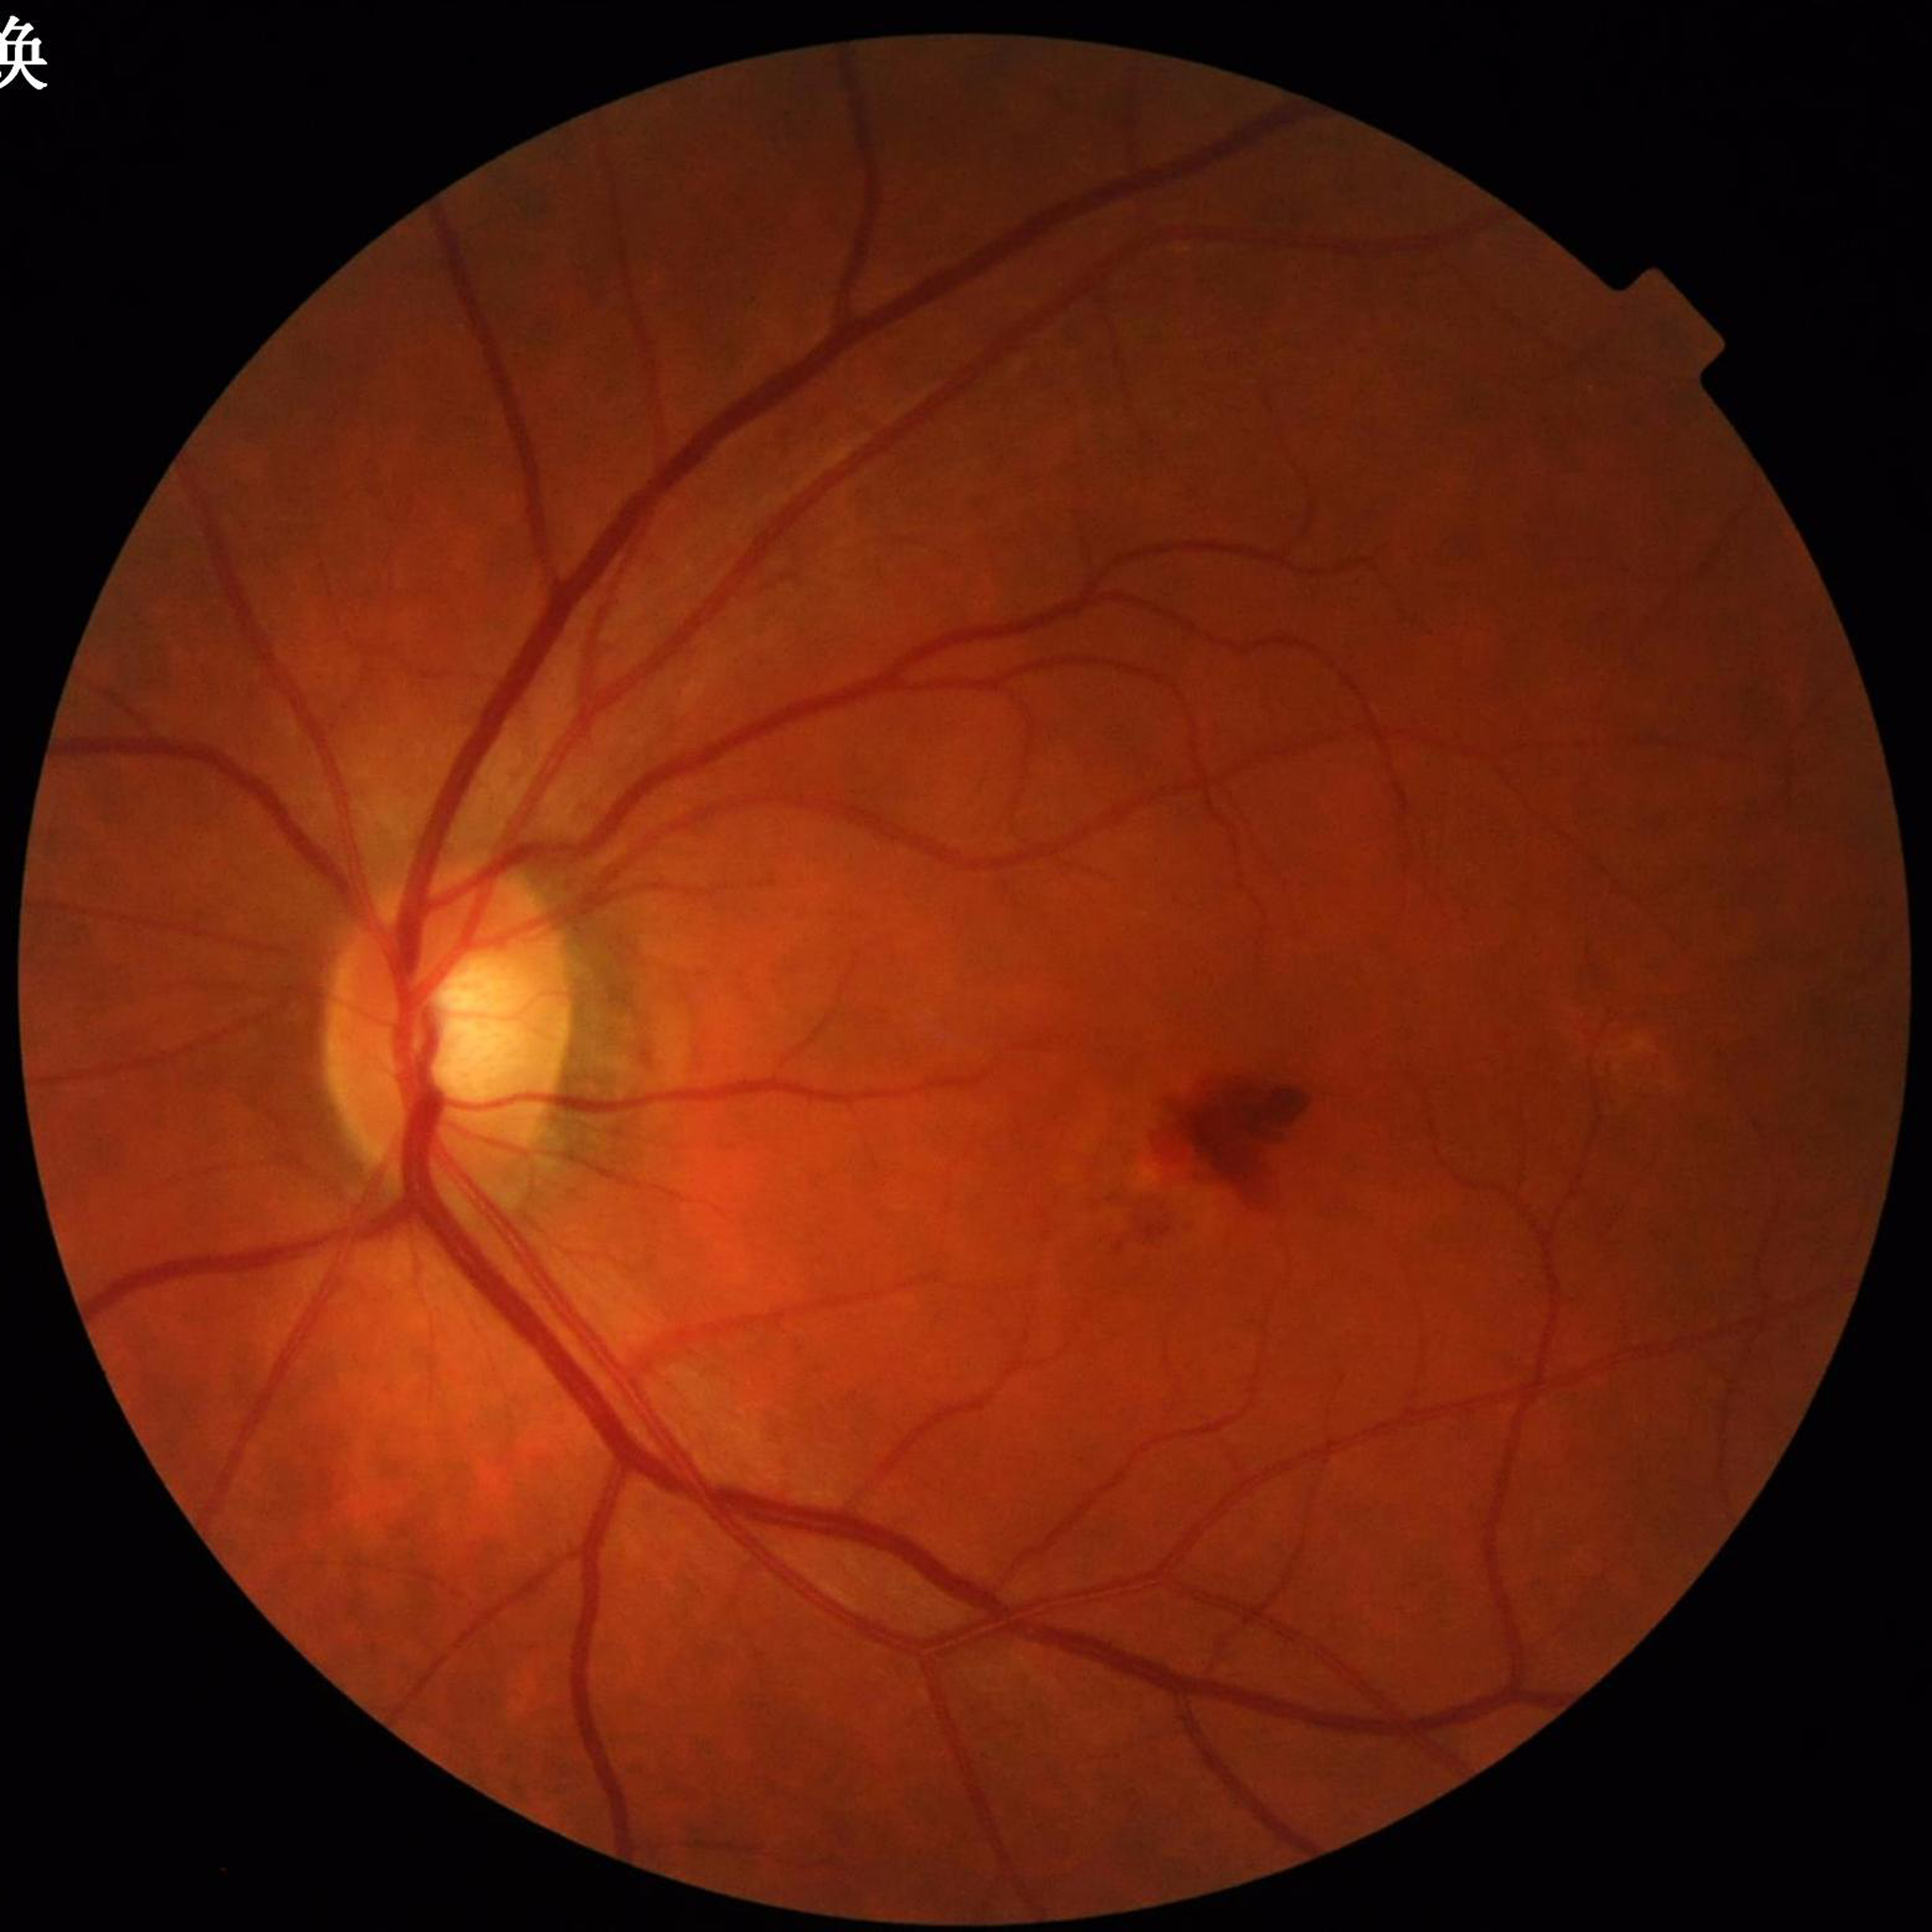

Automated quality assessment: no quality issues identified. Color fundus photograph from a patient diagnosed with AMD.